1240x1240 · 100° field of view (Phoenix ICON) · Phoenix ICON wide-field infant fundus image.
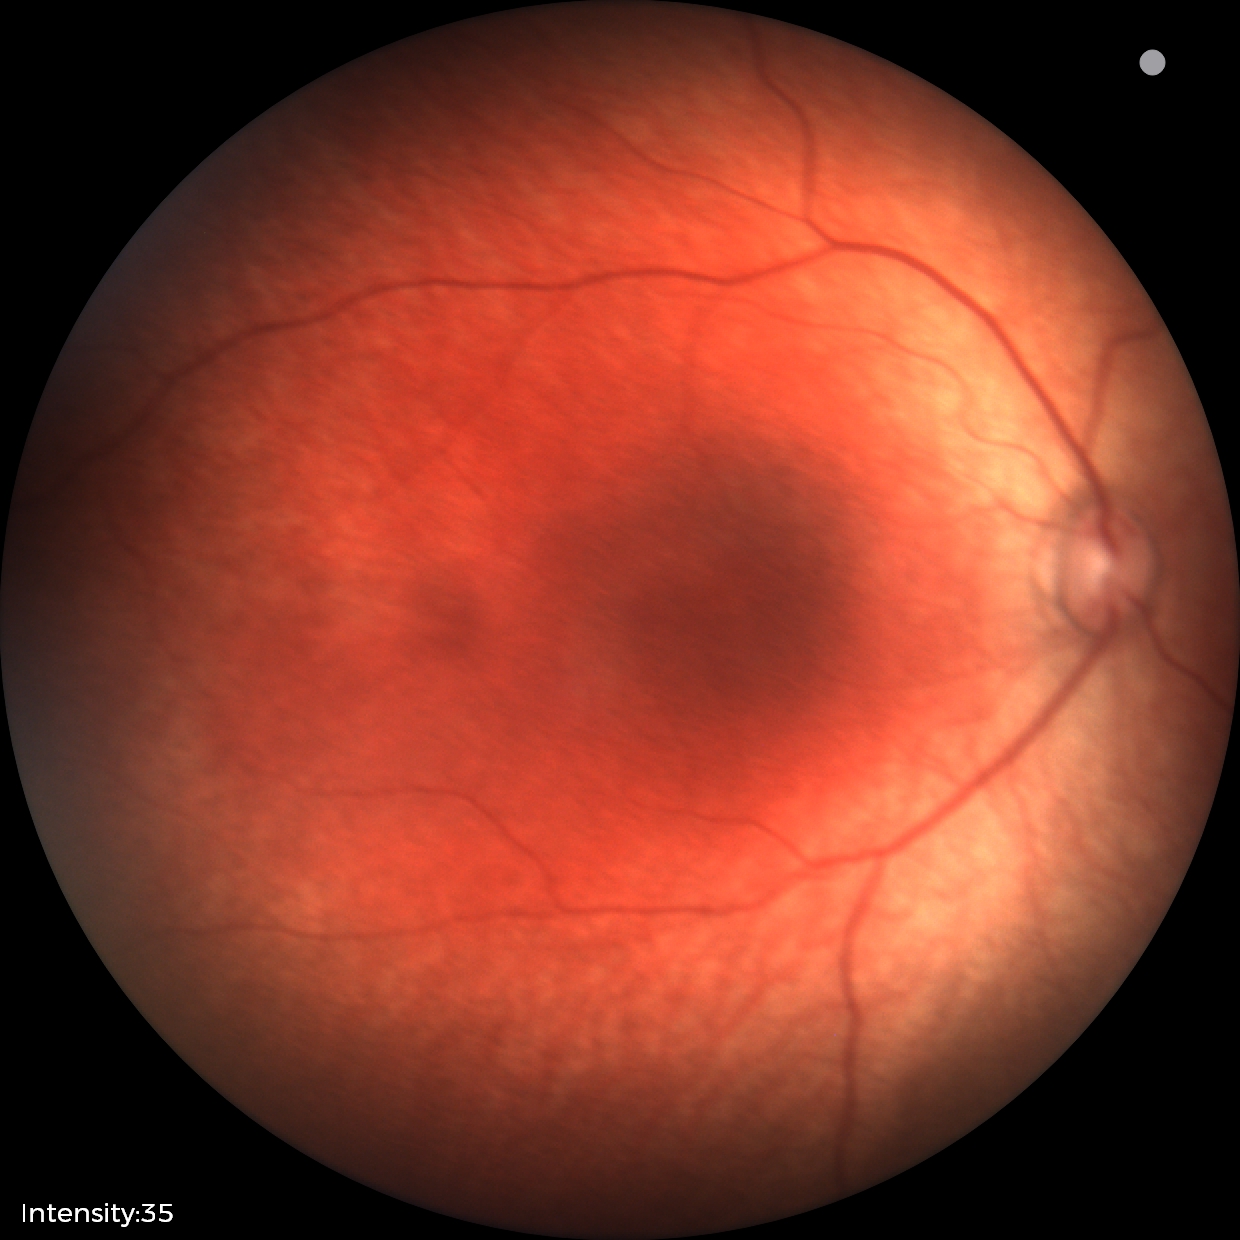 Physiological retinal appearance for postconceptual age.